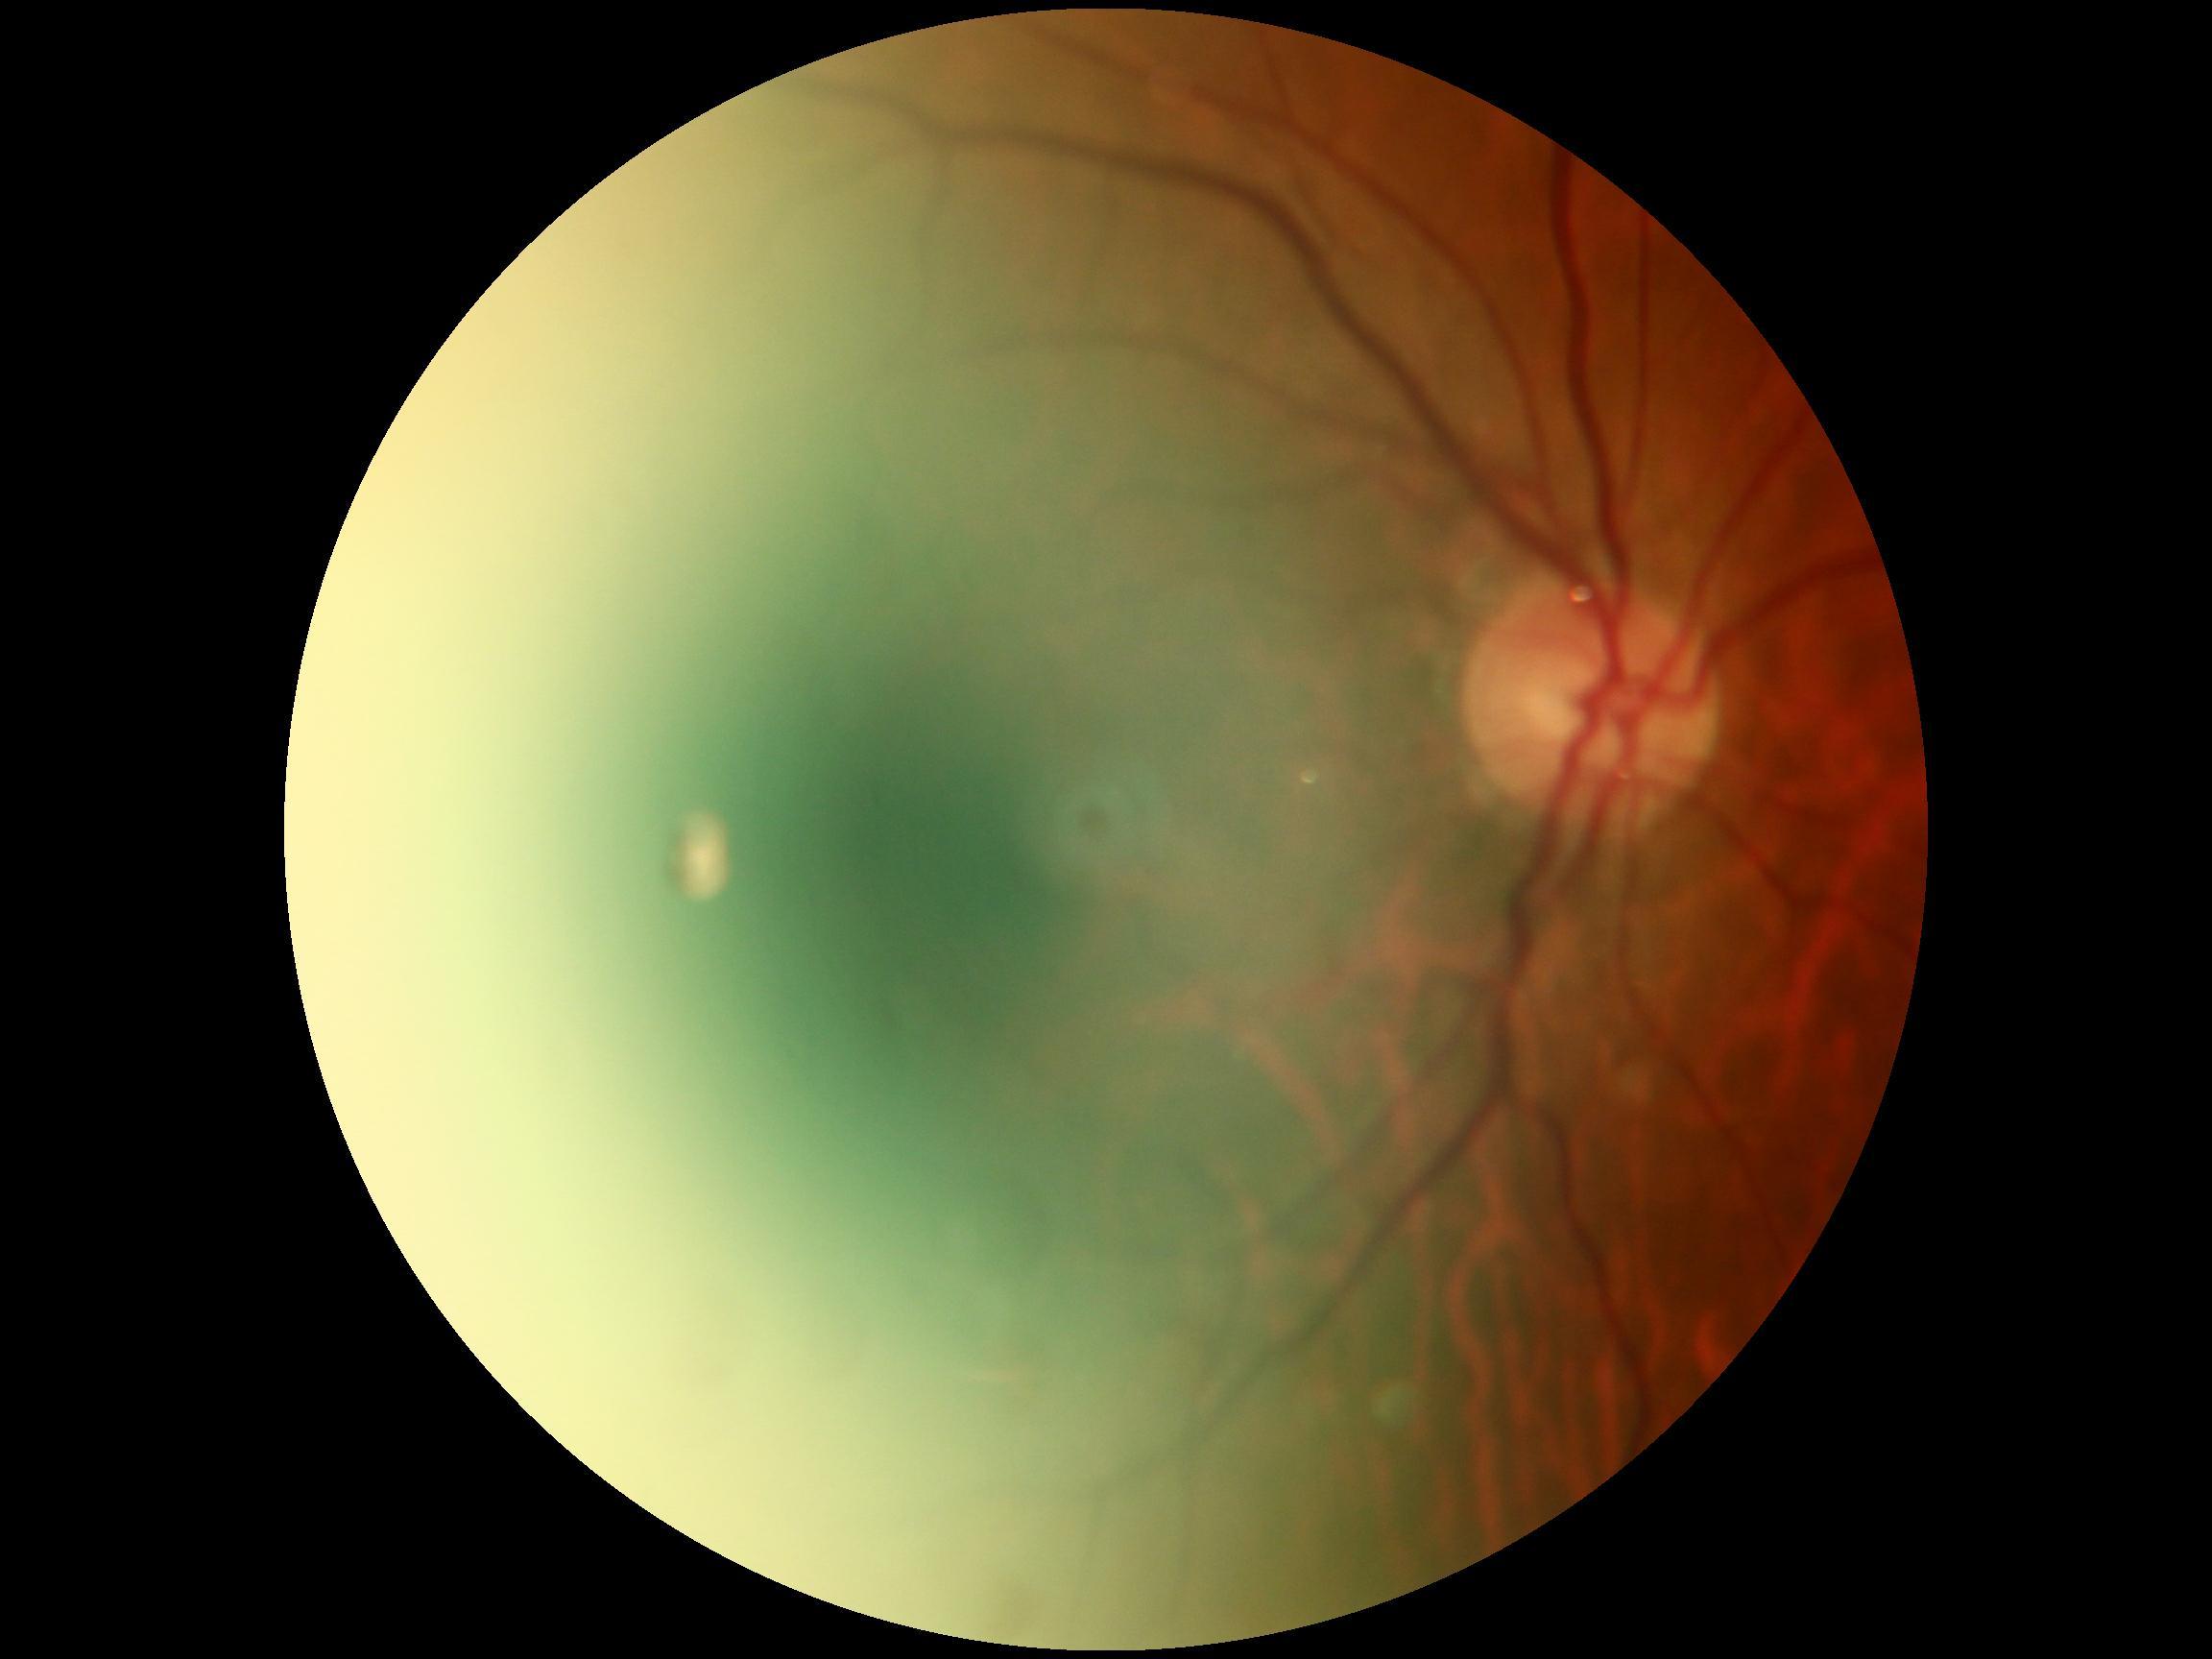
No DR findings.
DR: grade 0 (no apparent retinopathy).